Camera: Phoenix ICON (100° FOV) · pediatric wide-field fundus photograph: 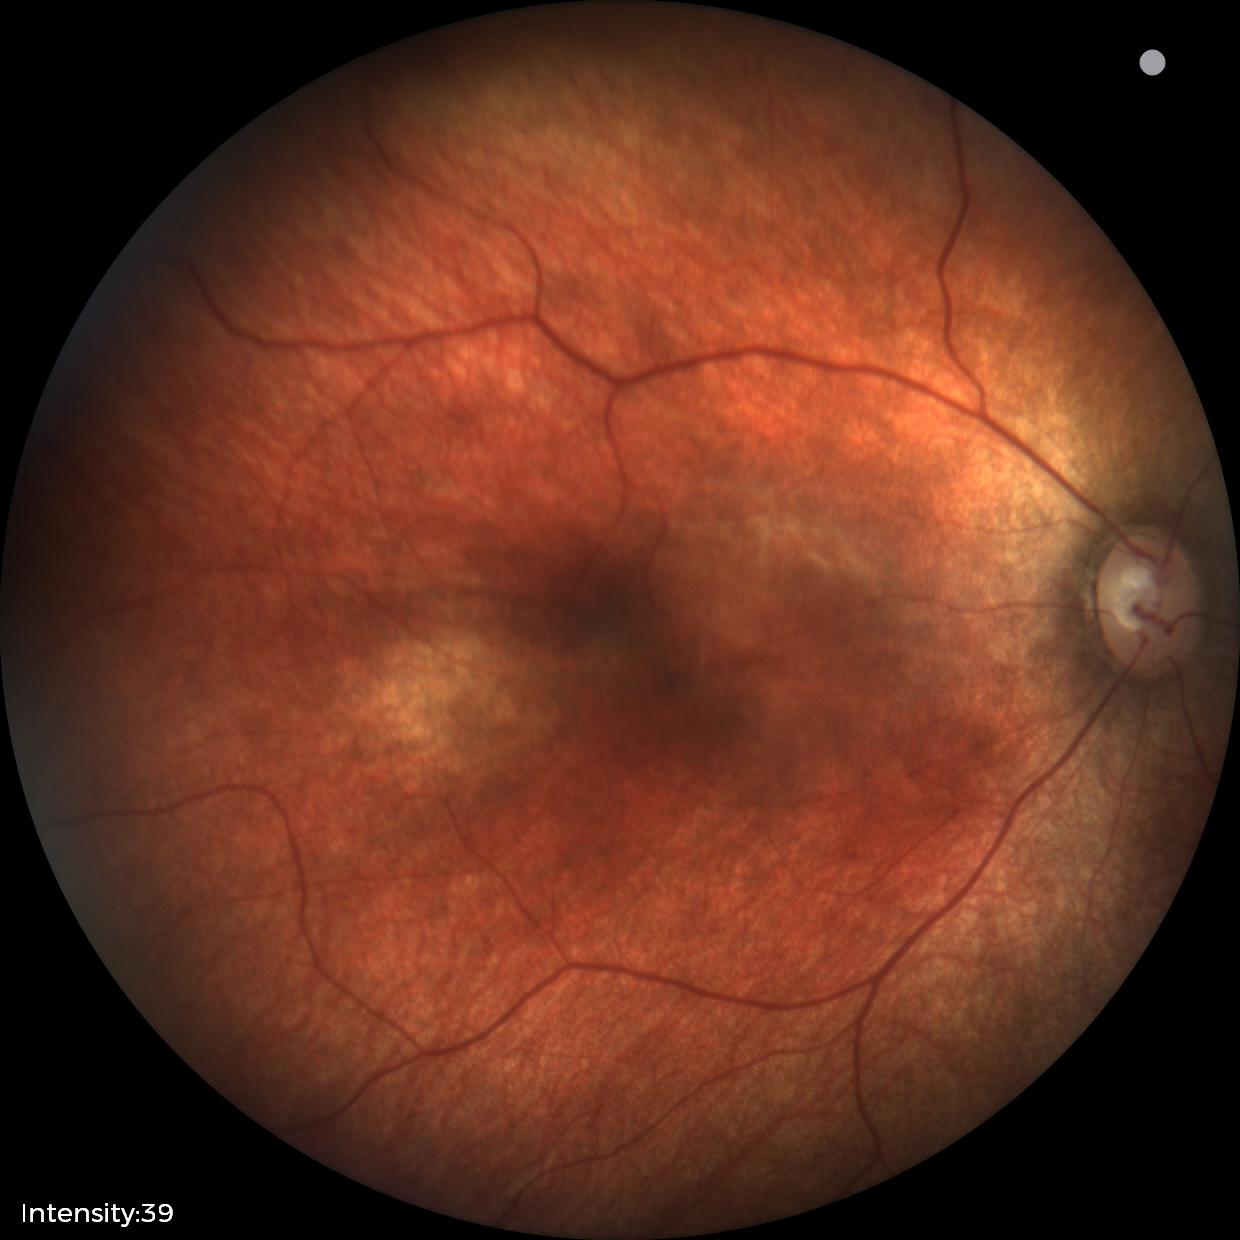
No retinal pathology identified on screening.